45° field of view · 2048x1536
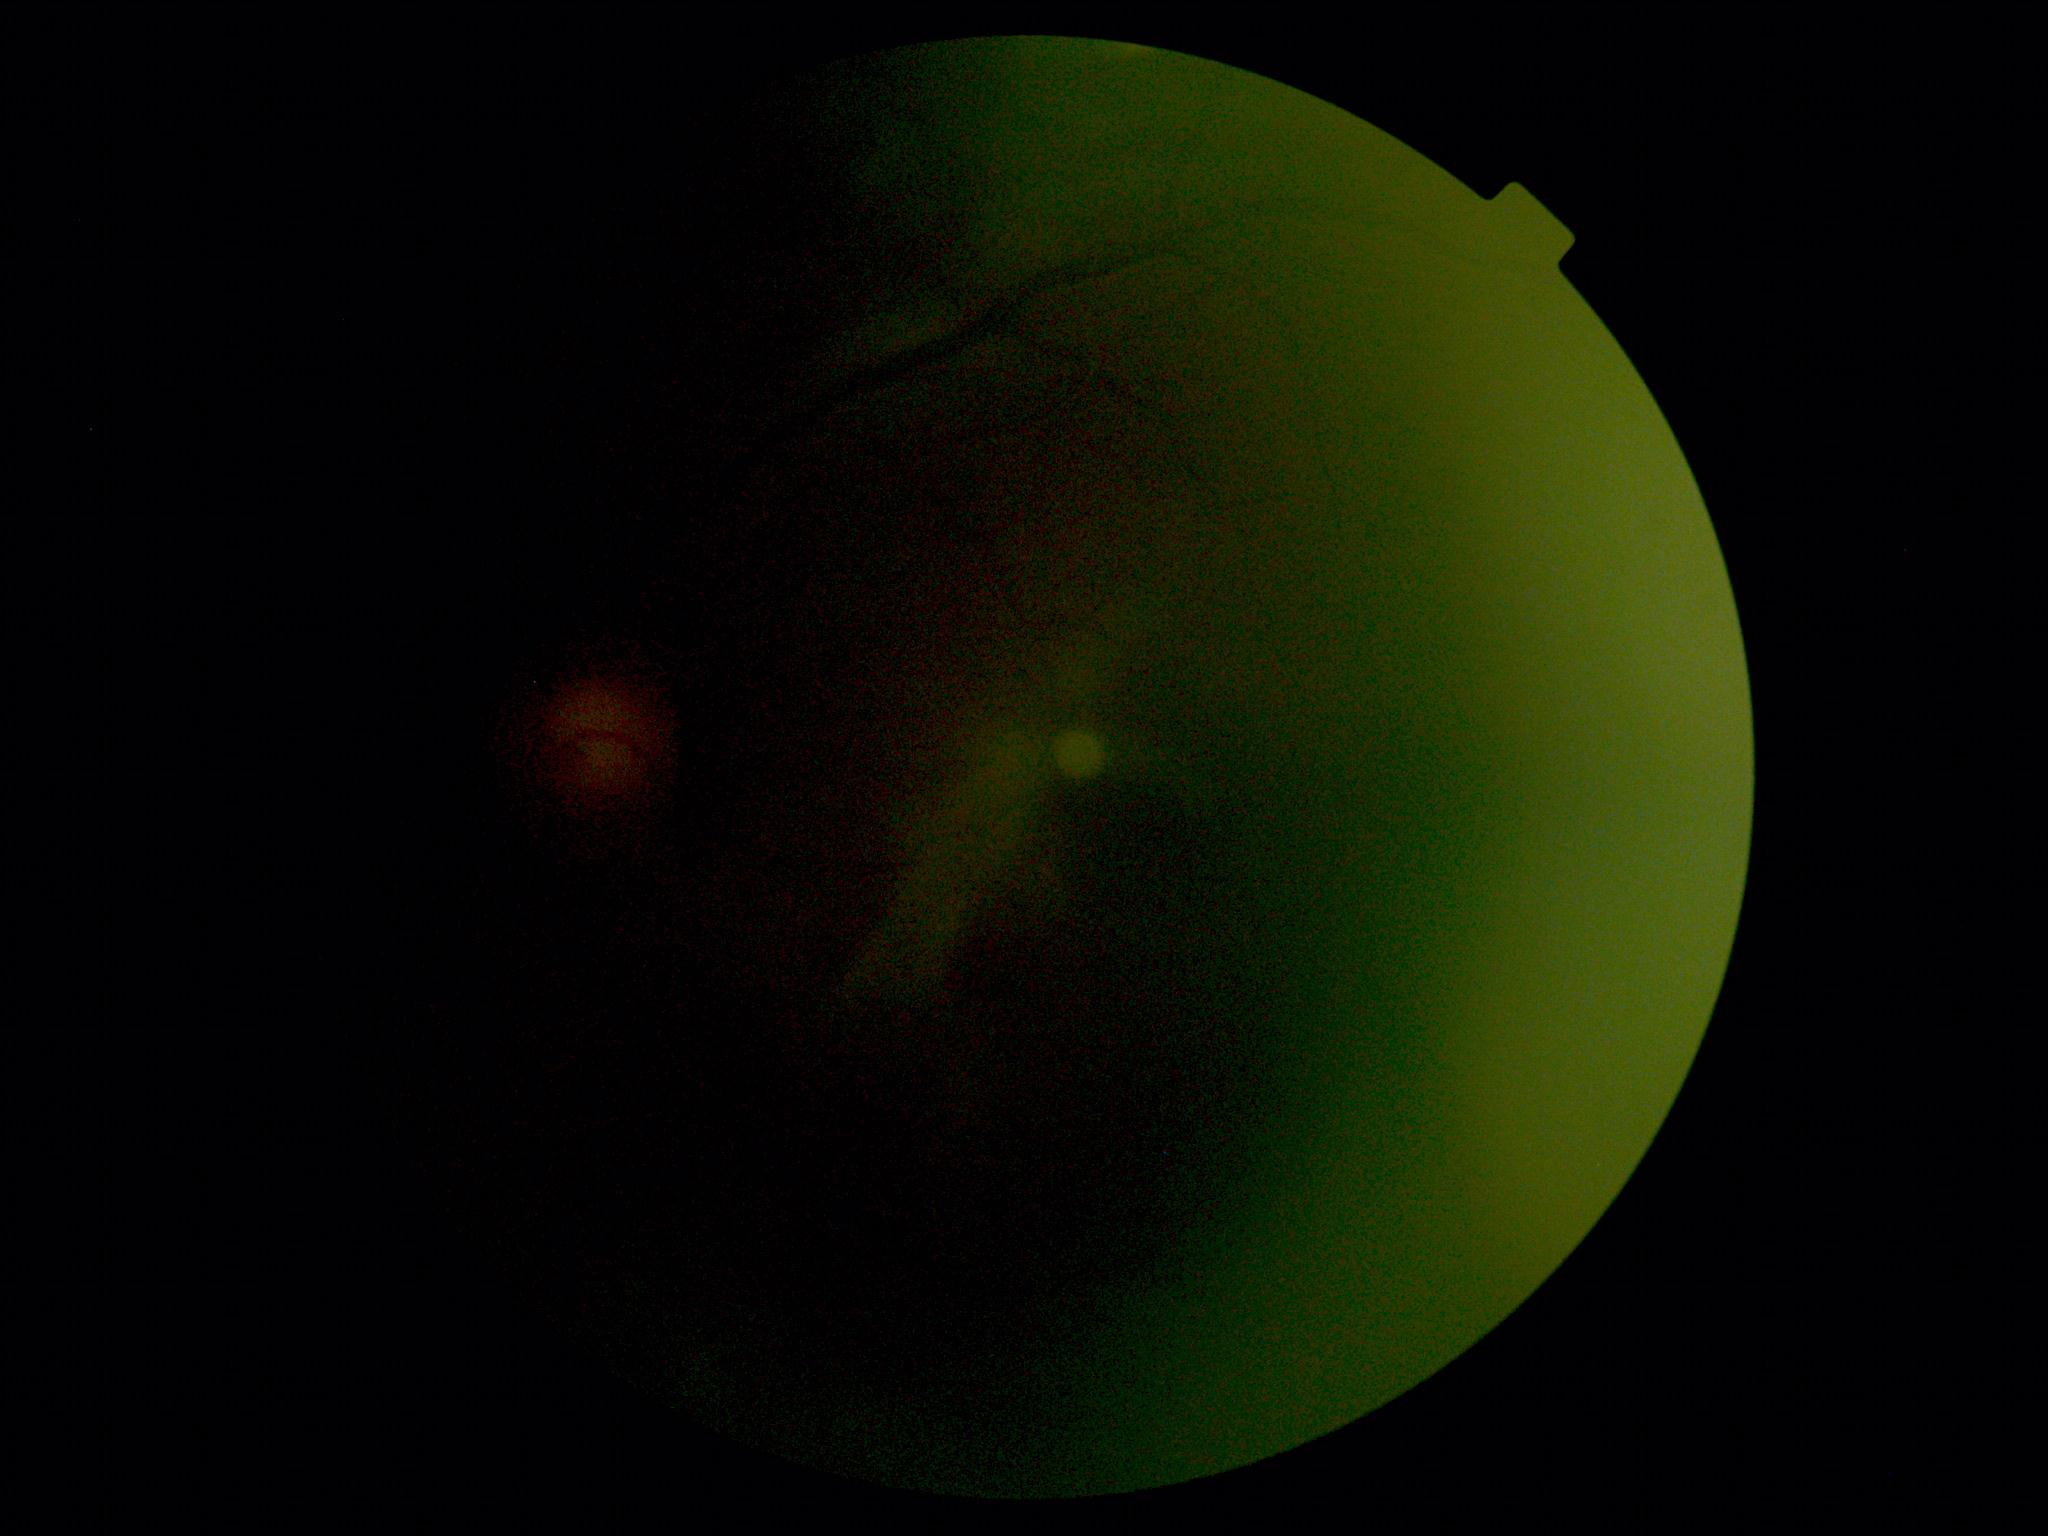
Quality too poor to assess for DR.
Diabetic retinopathy severity is ungradable due to poor image quality.